Wide-field contact fundus photograph of an infant — 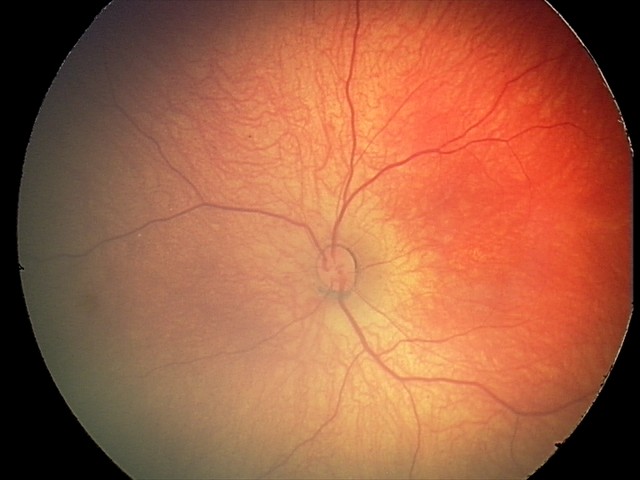

Q: What is the screening diagnosis?
A: retinal hemorrhages